Without pupil dilation. 45 degree fundus photograph. Image size 848x848:
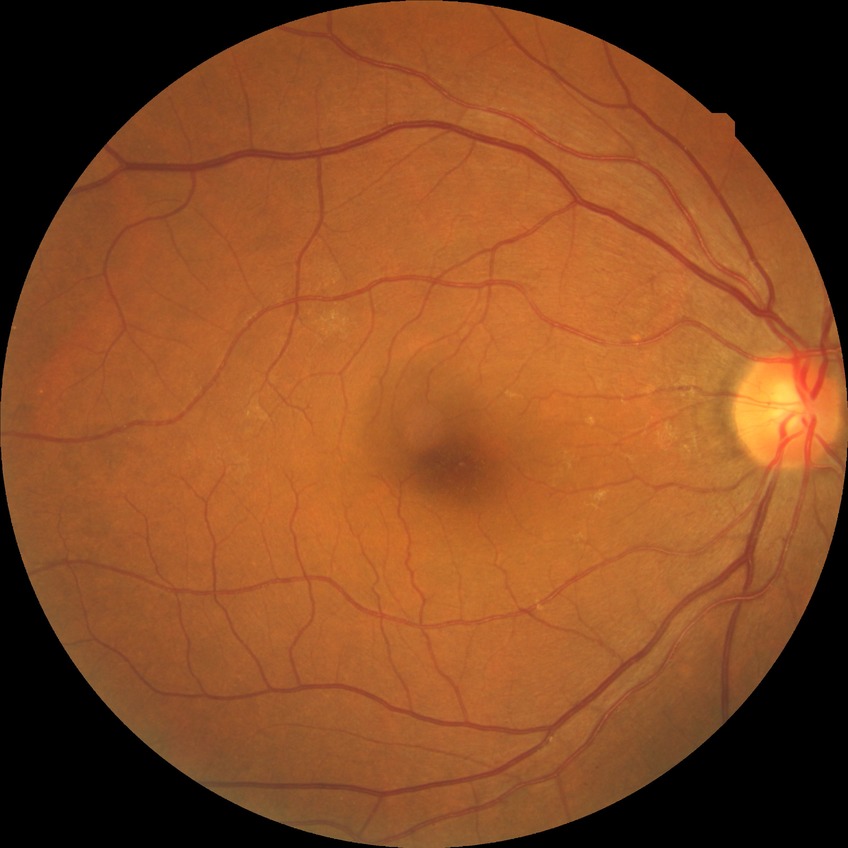

{
  "davis_grade": "NDR"
}